Davis DR grading; nonmydriatic.
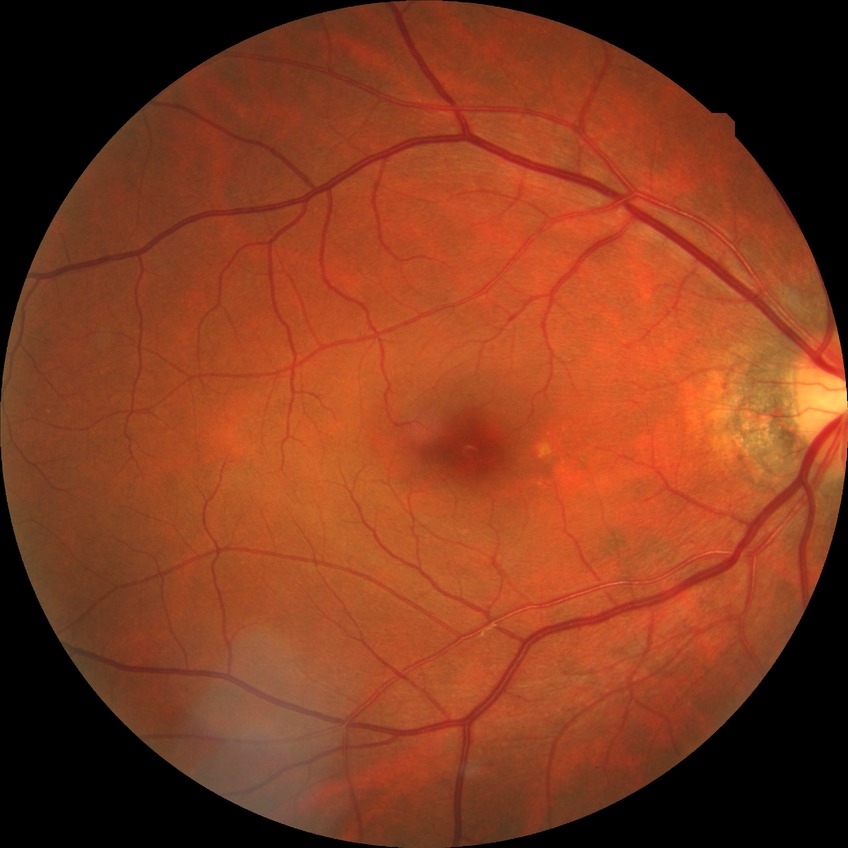

Assessment:
– diabetic retinopathy (DR): NDR (no diabetic retinopathy)